50° FOV; CFP; dilated-pupil acquisition.
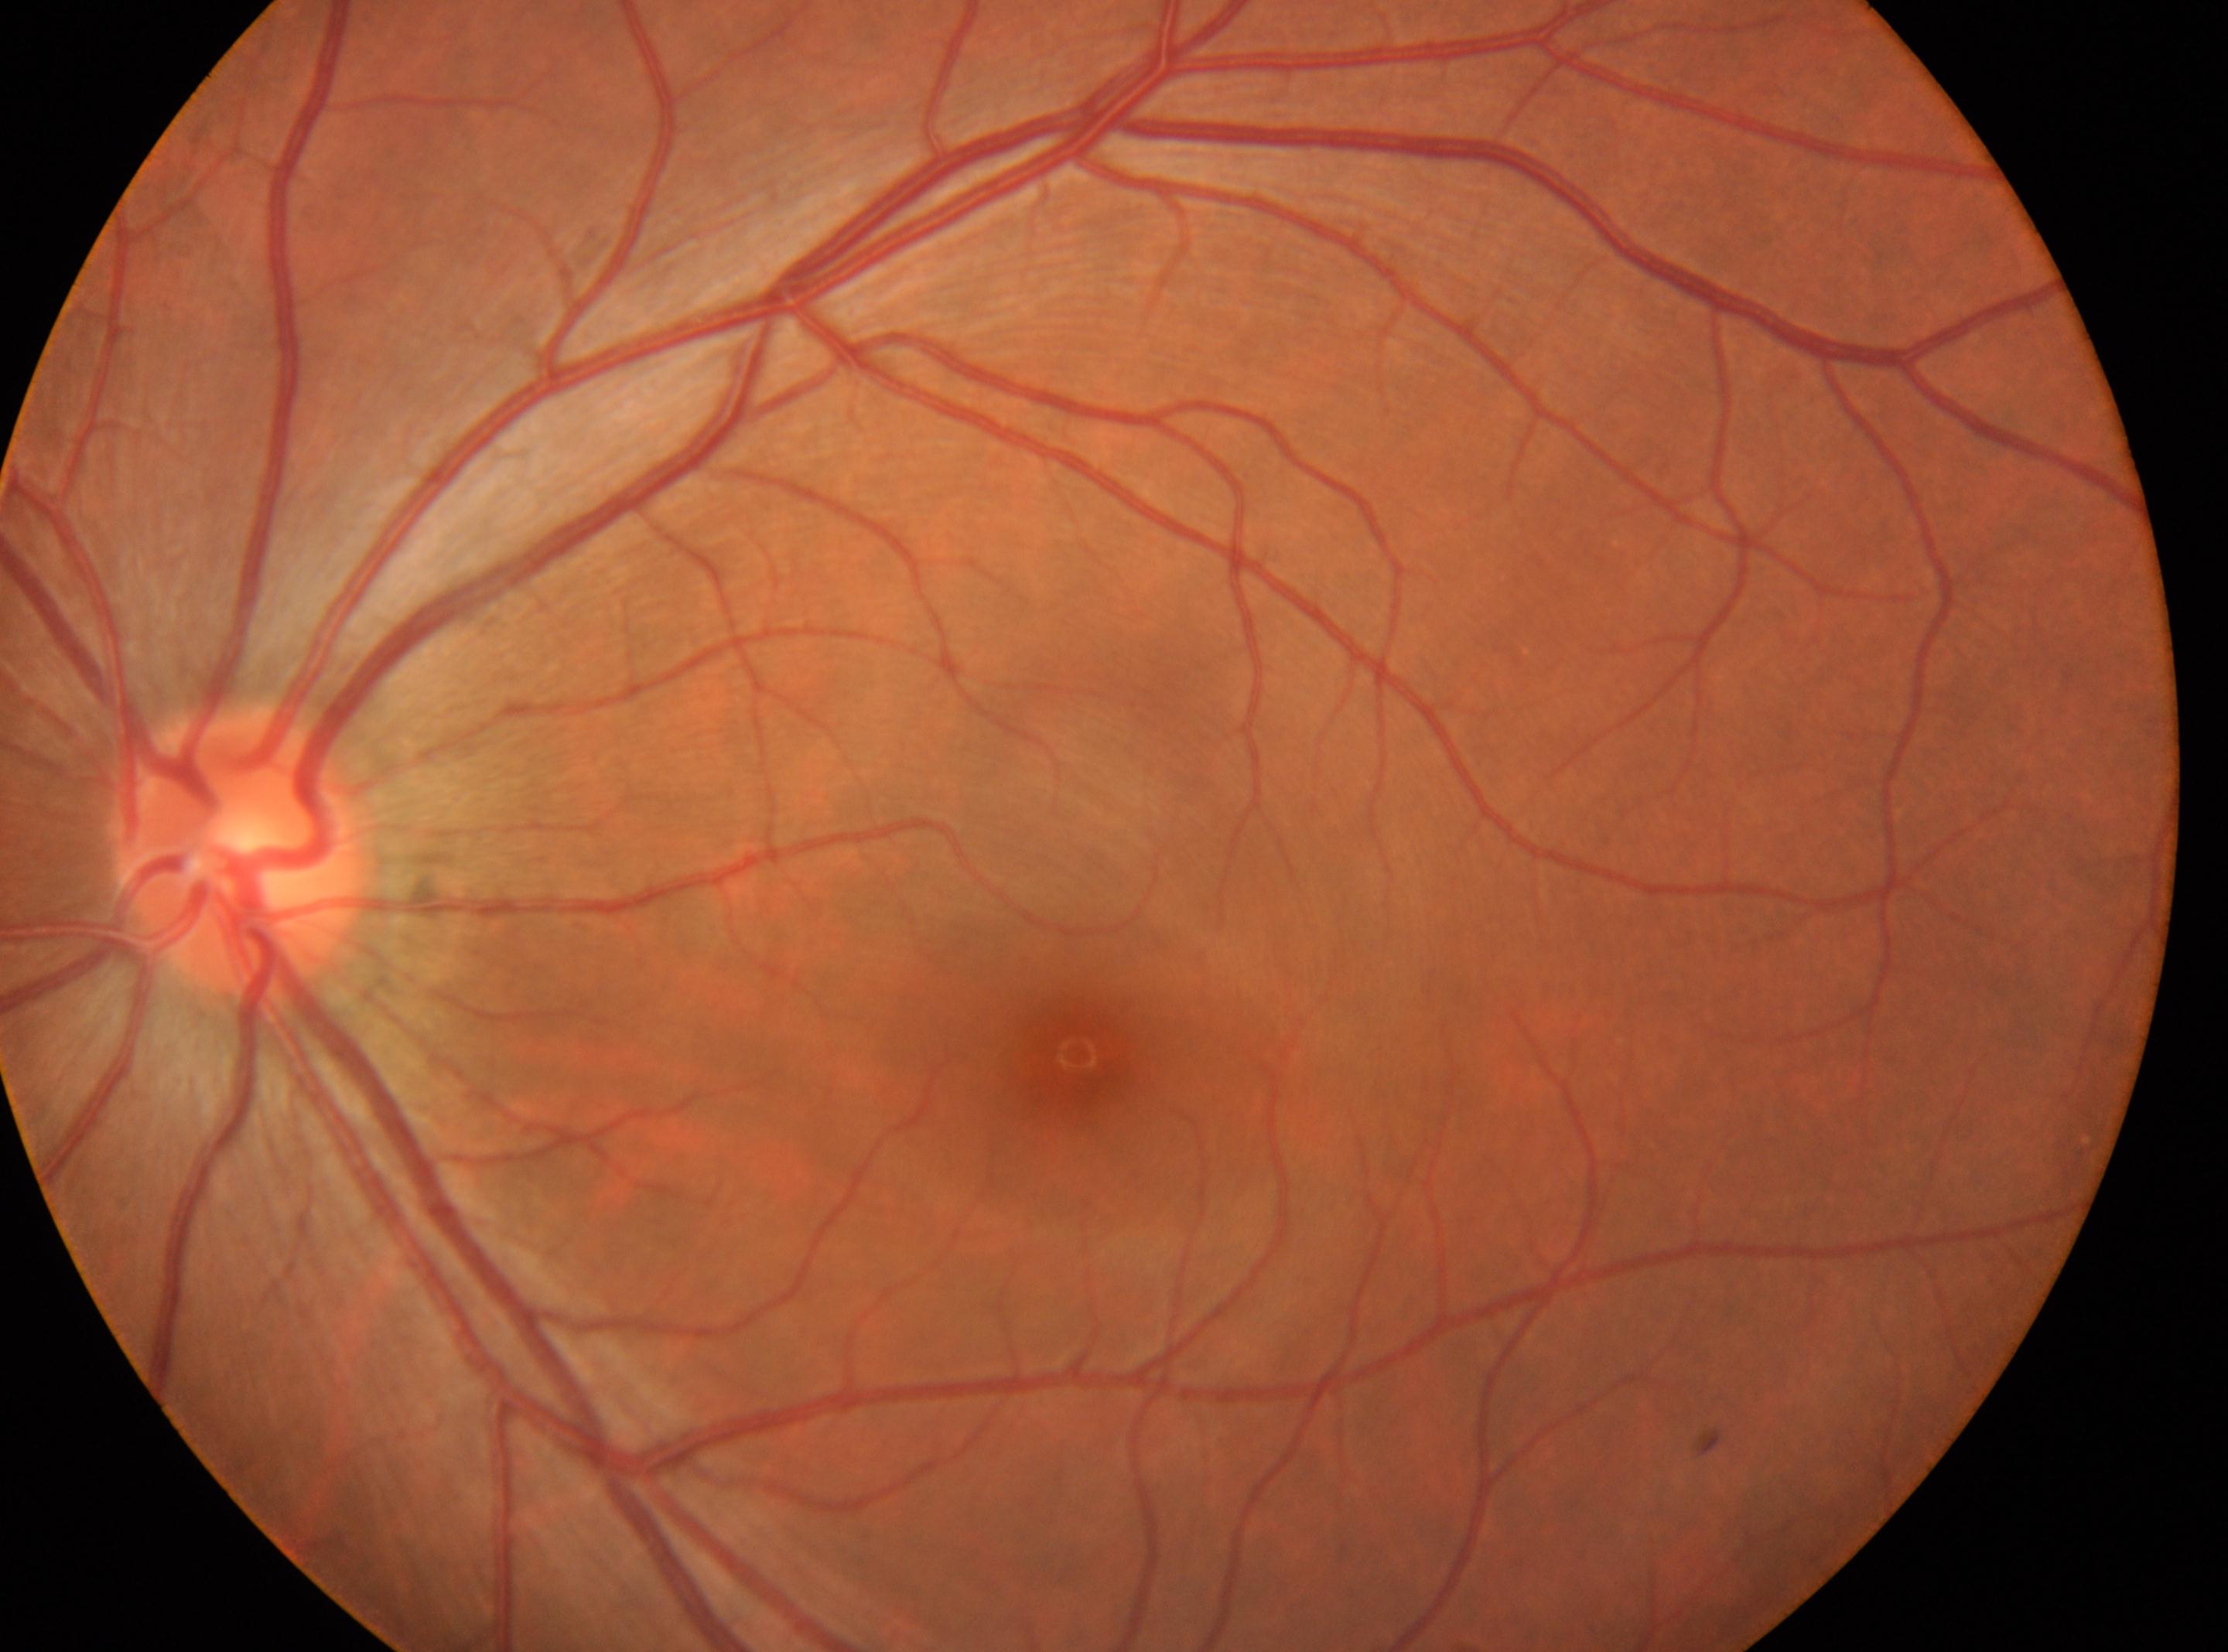
This is the left eye. Retinopathy grade is 0. Optic disc: [241, 854]. Macular center: [1075, 1052].